CFP, 45° FOV: 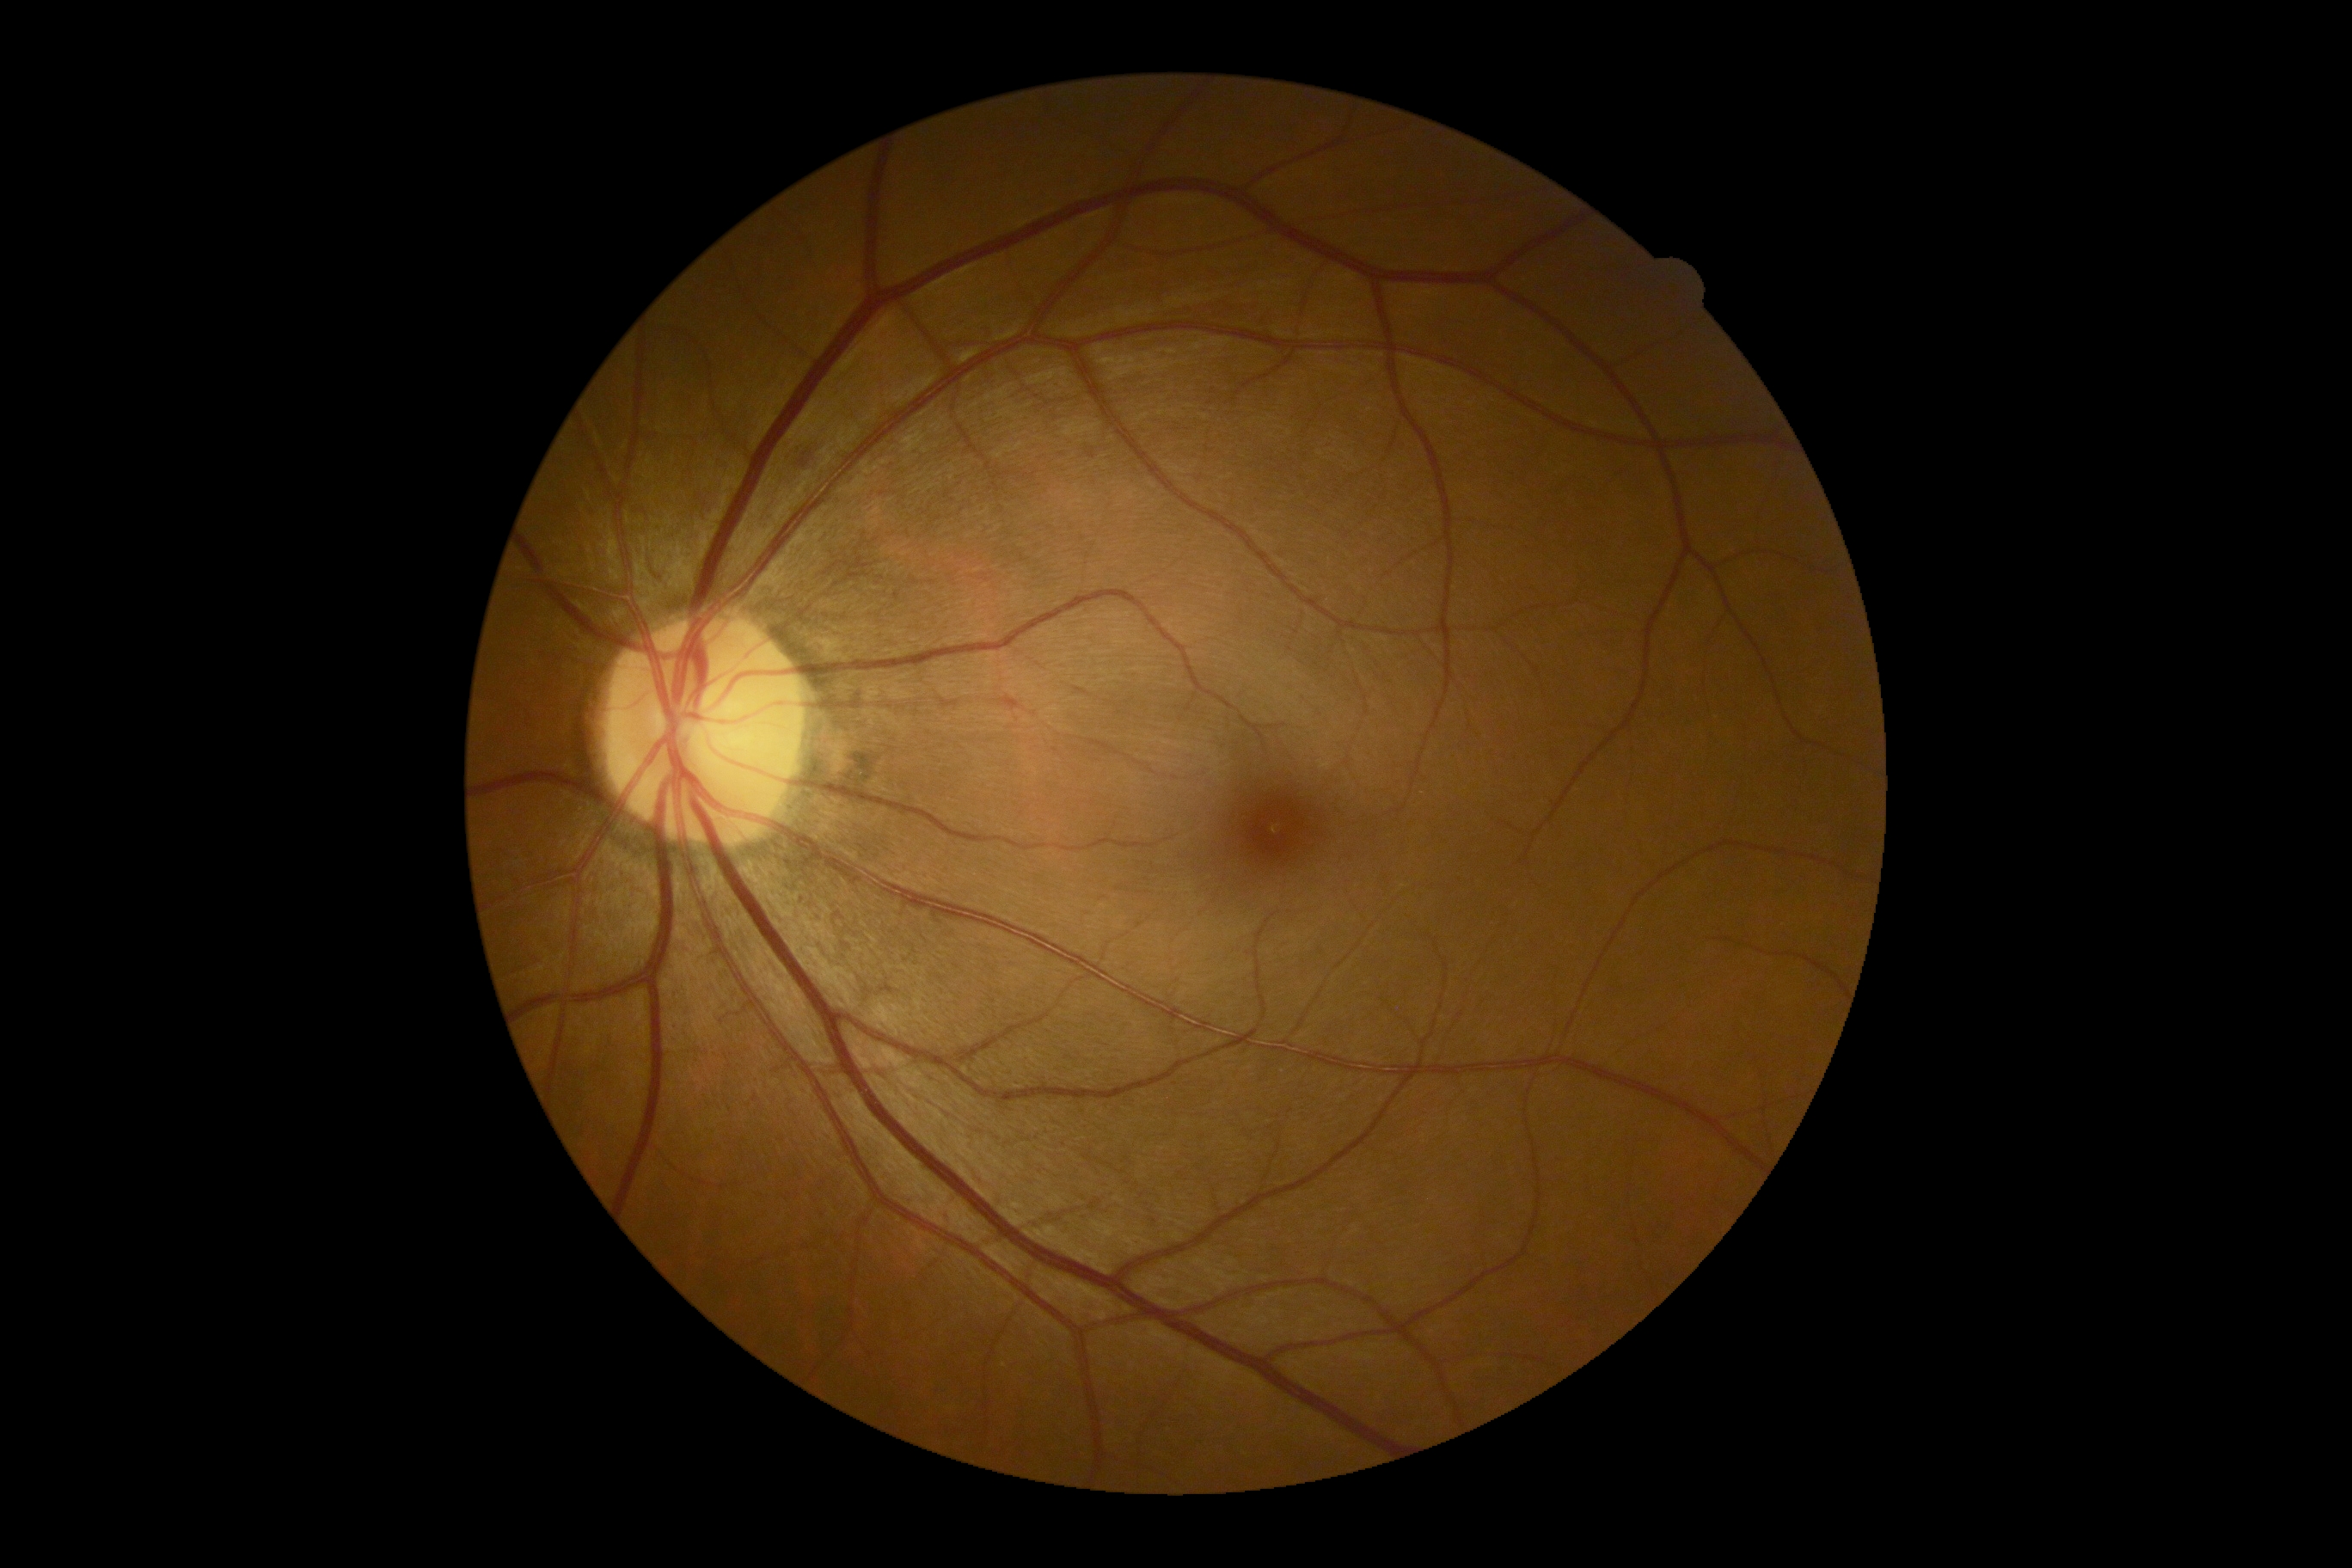
Retinopathy: 2/4.